Infant wide-field fundus photograph.
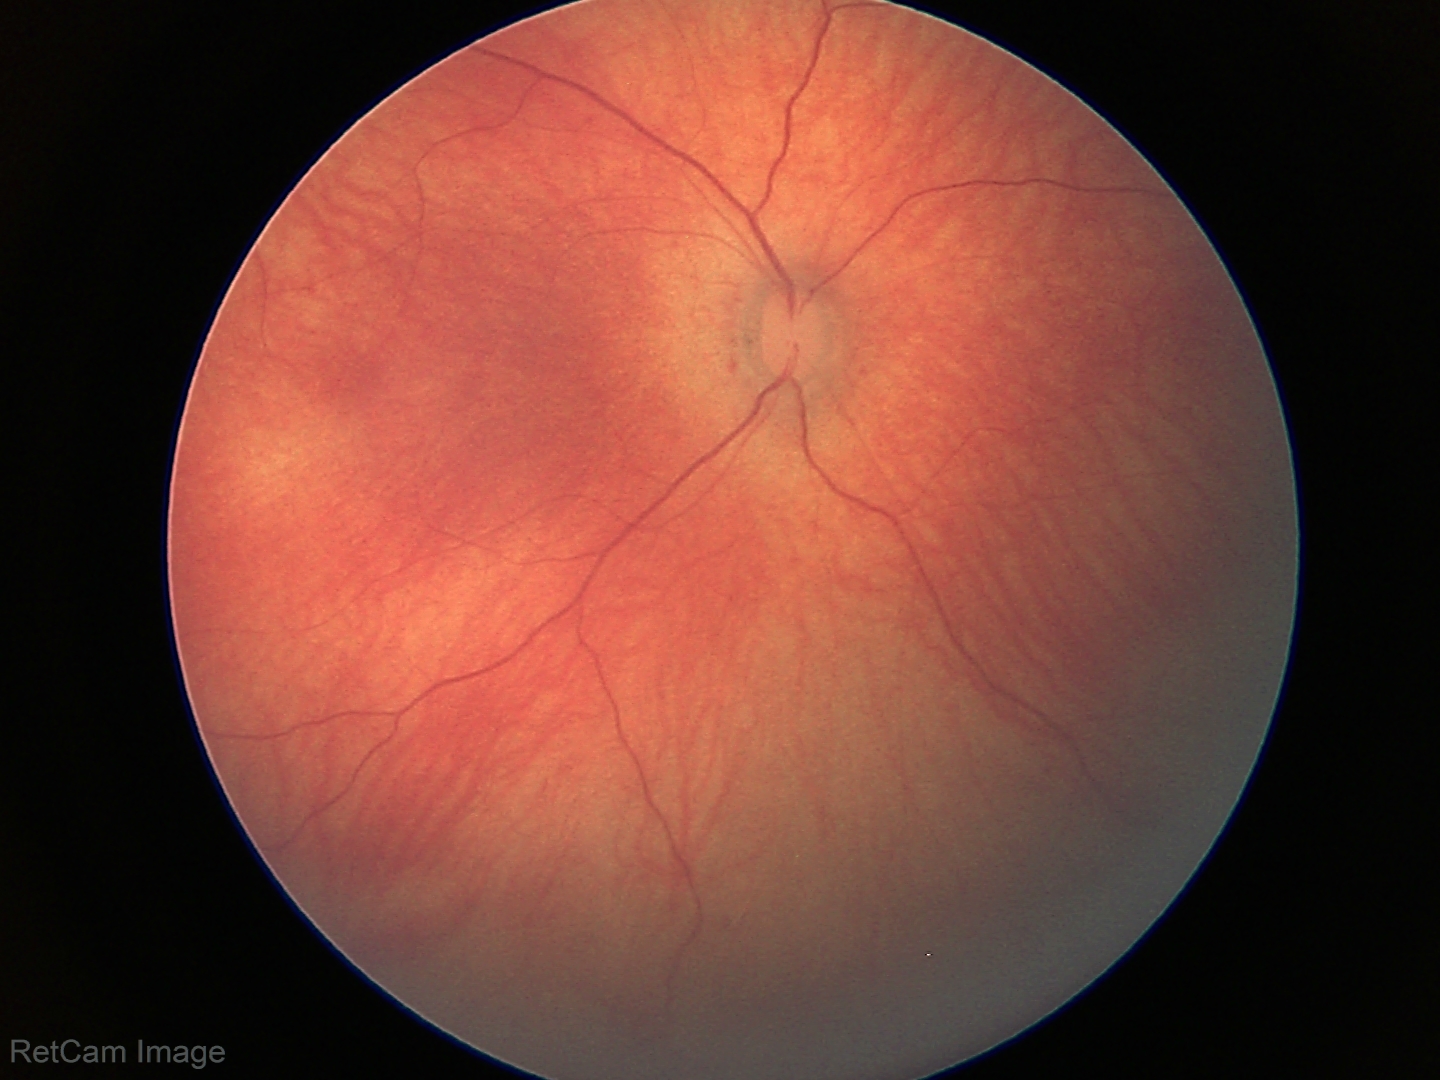
Screening: physiological appearance with no retinal pathology.